Acquired with a NIDEK AFC-230:
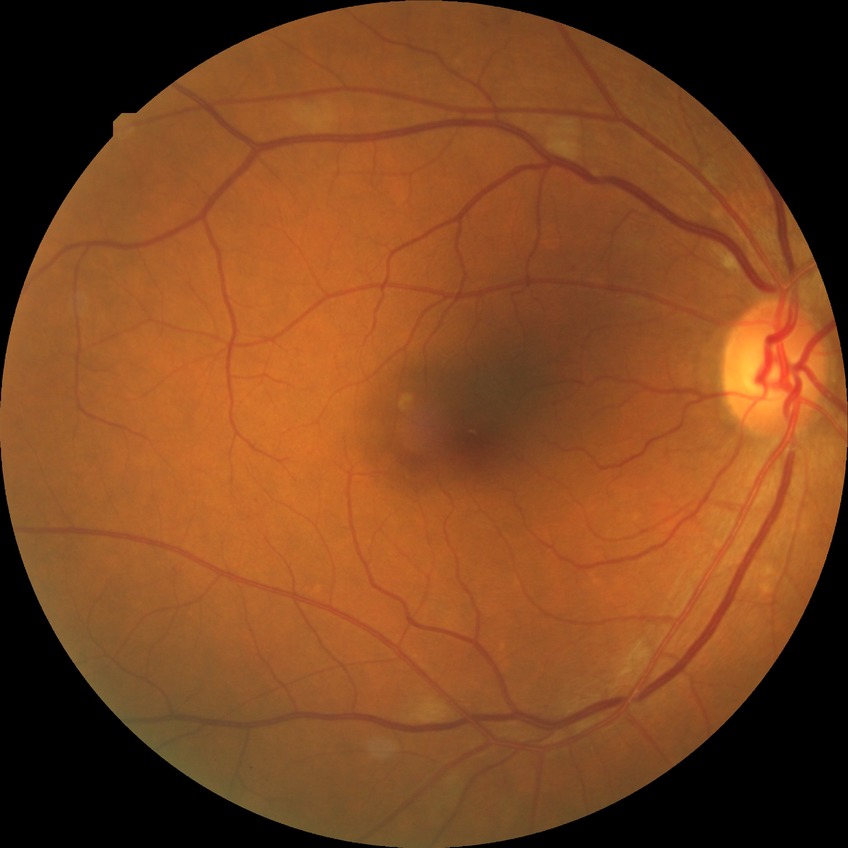

DR class: non-proliferative diabetic retinopathy | diabetic retinopathy (DR): SDR (simple diabetic retinopathy).